Acquired on the Natus RetCam Envision. Infant wide-field fundus photograph.
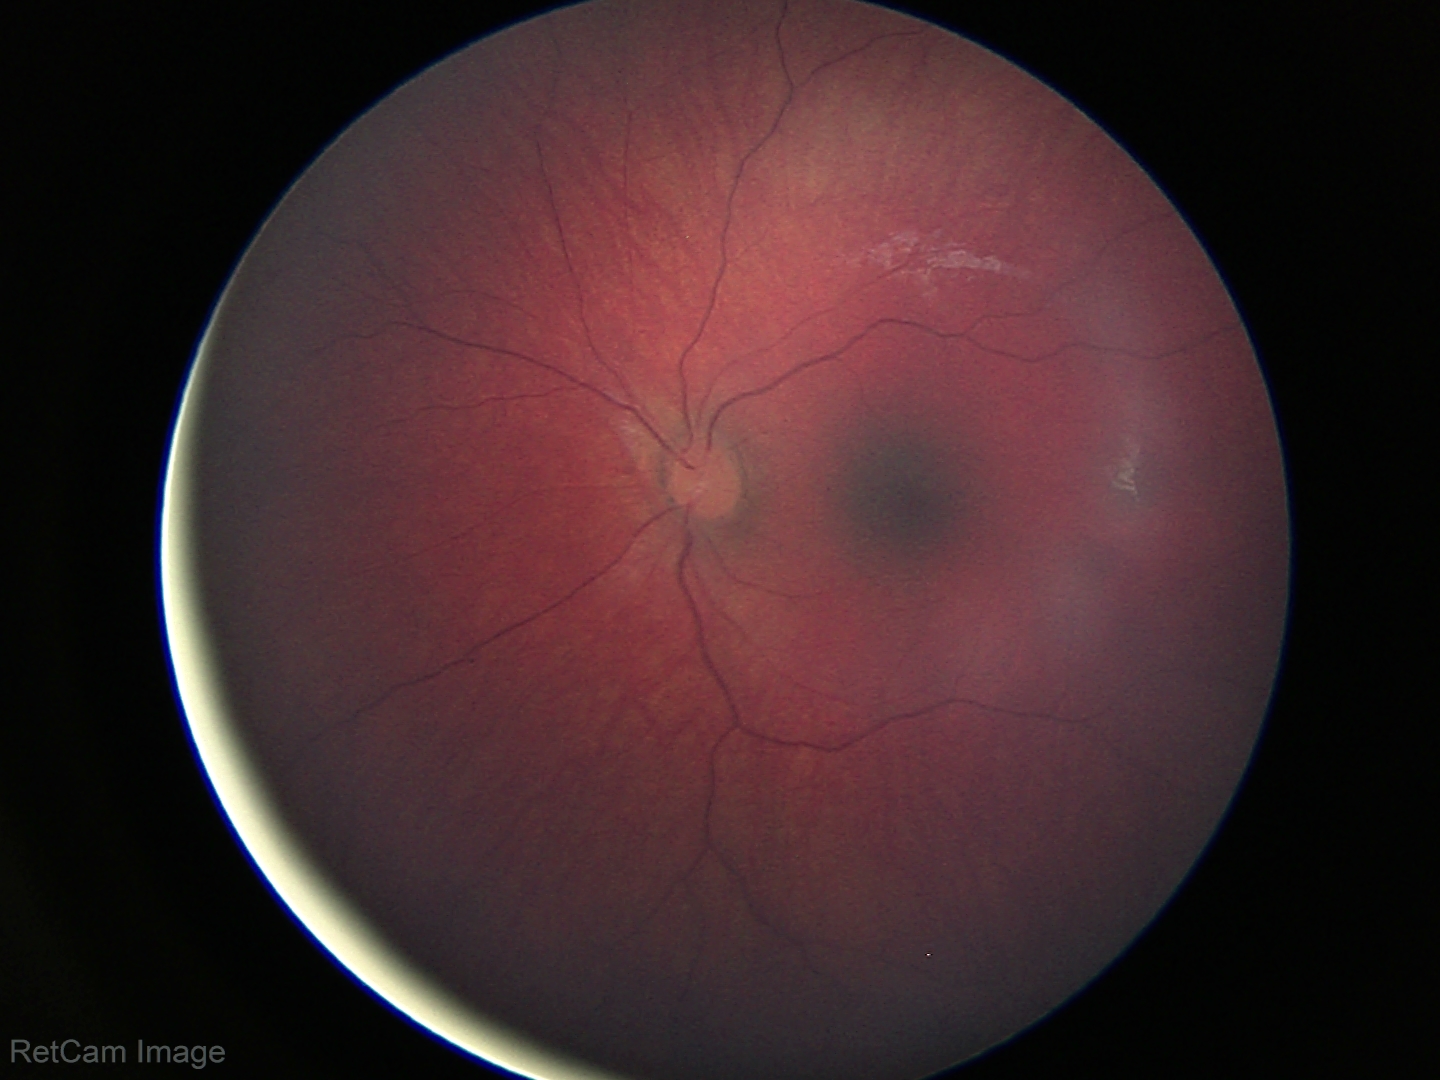

Physiological retinal appearance for postconceptual age.